Wide-field fundus photograph of an infant: 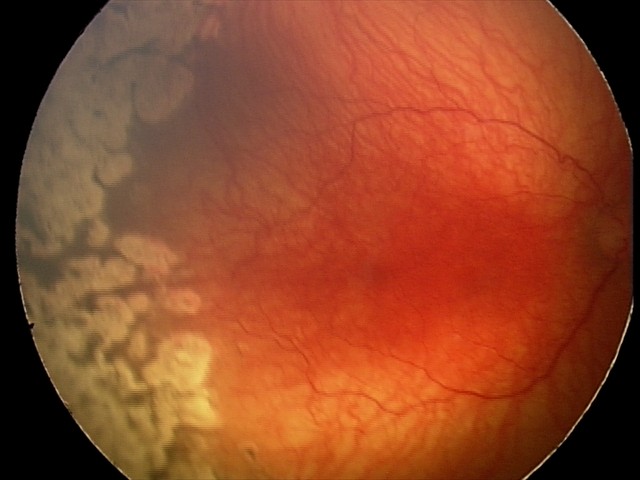 Screening examination consistent with A-ROP (aggressive ROP) — rapidly progressive severe ROP with prominent plus disease, often without classic stage progression.
Plus disease present.